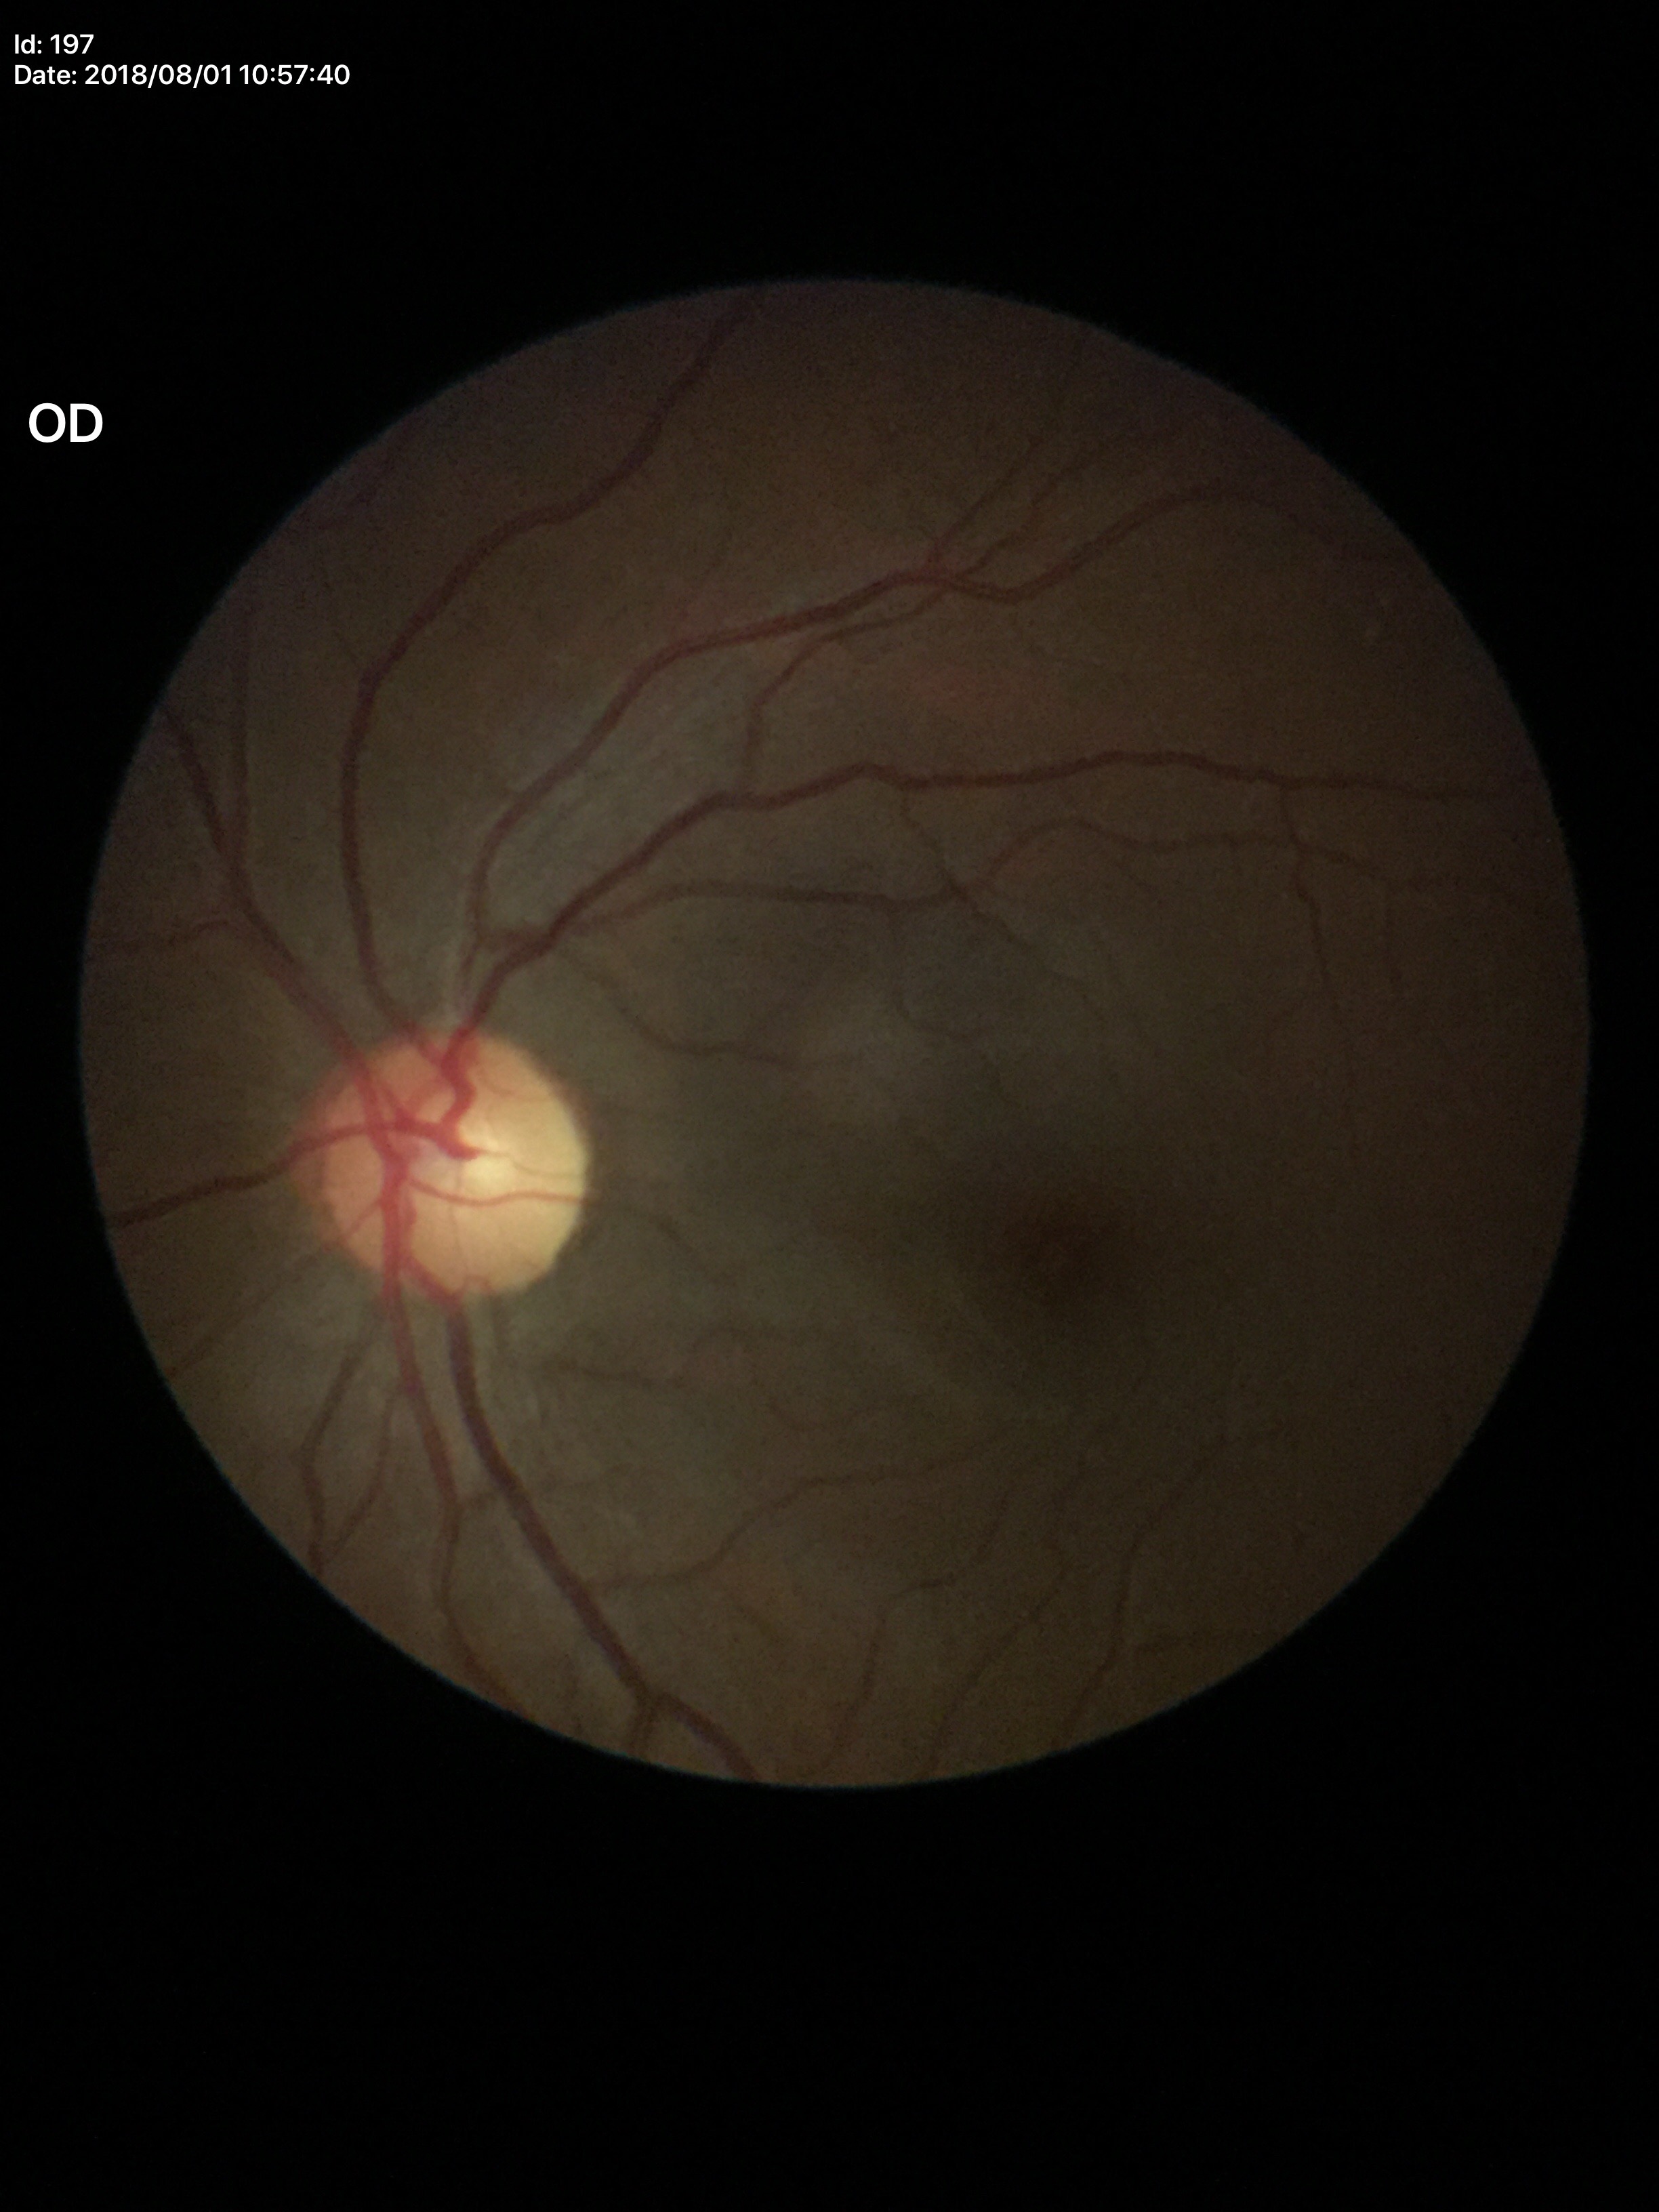 Horizontal CDR (HCDR) of 0.54.
Vertical cup-to-disc ratio (VCDR) of 0.51.
Glaucoma assessment: negative.